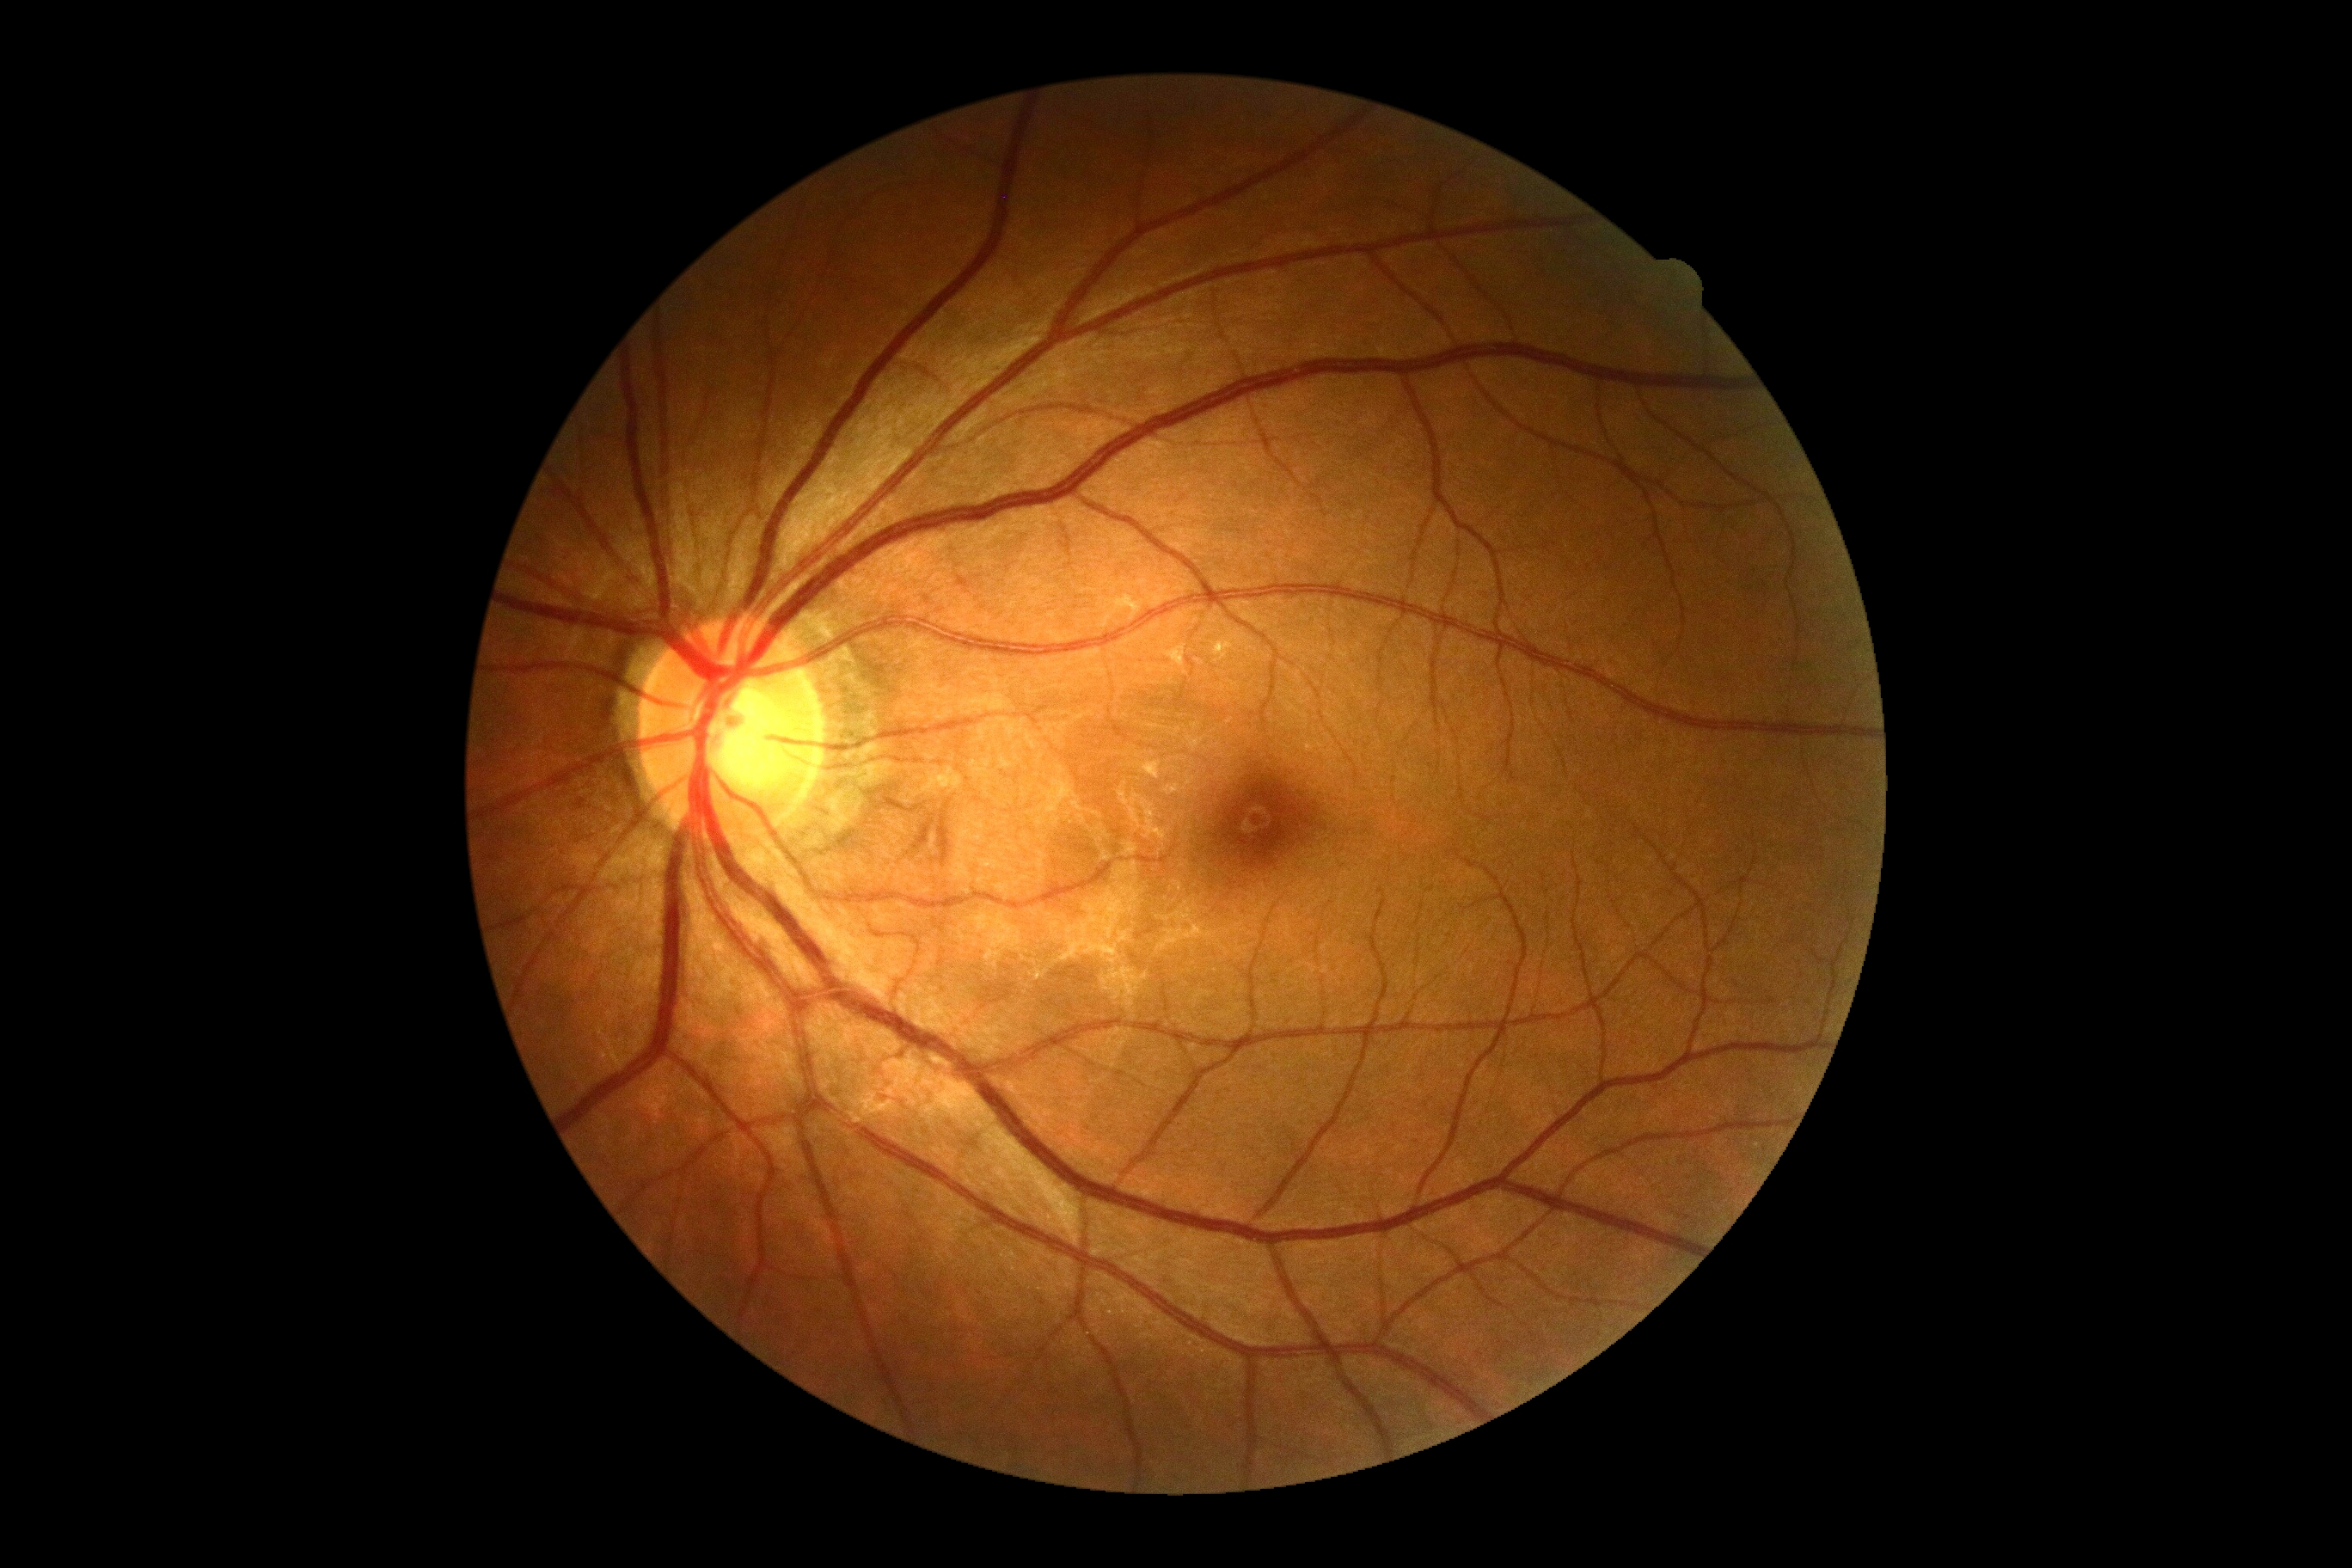

DR is no apparent diabetic retinopathy (grade 0).